Diabetic retinopathy graded by the modified Davis classification · posterior pole color fundus photograph.
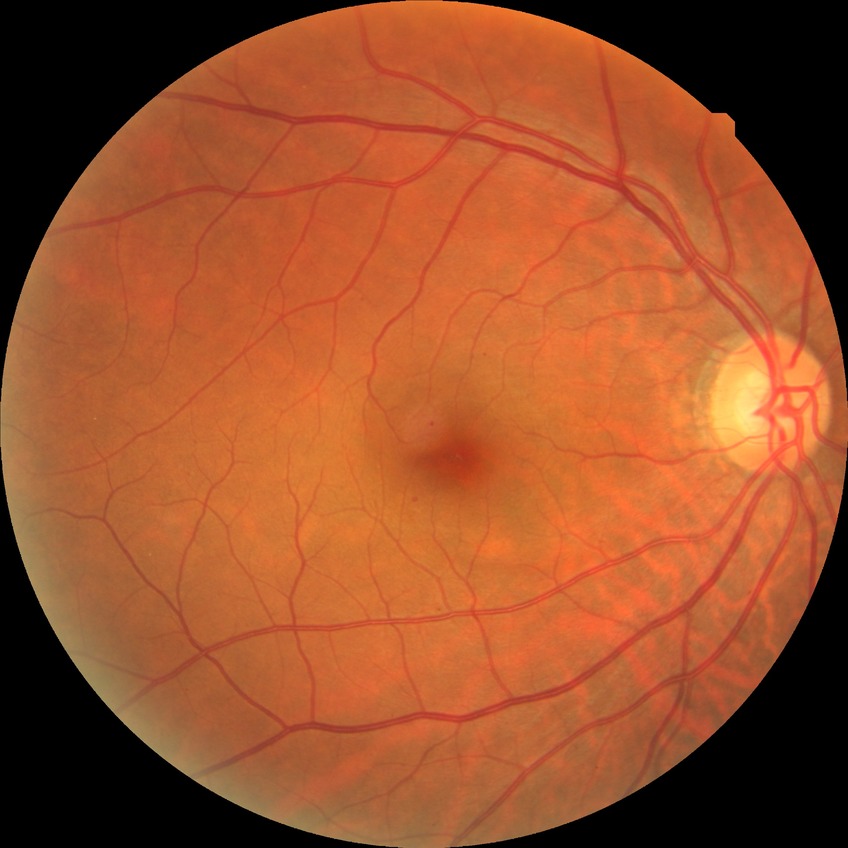 Diabetic retinopathy (DR): SDR (simple diabetic retinopathy).